Davis DR grading
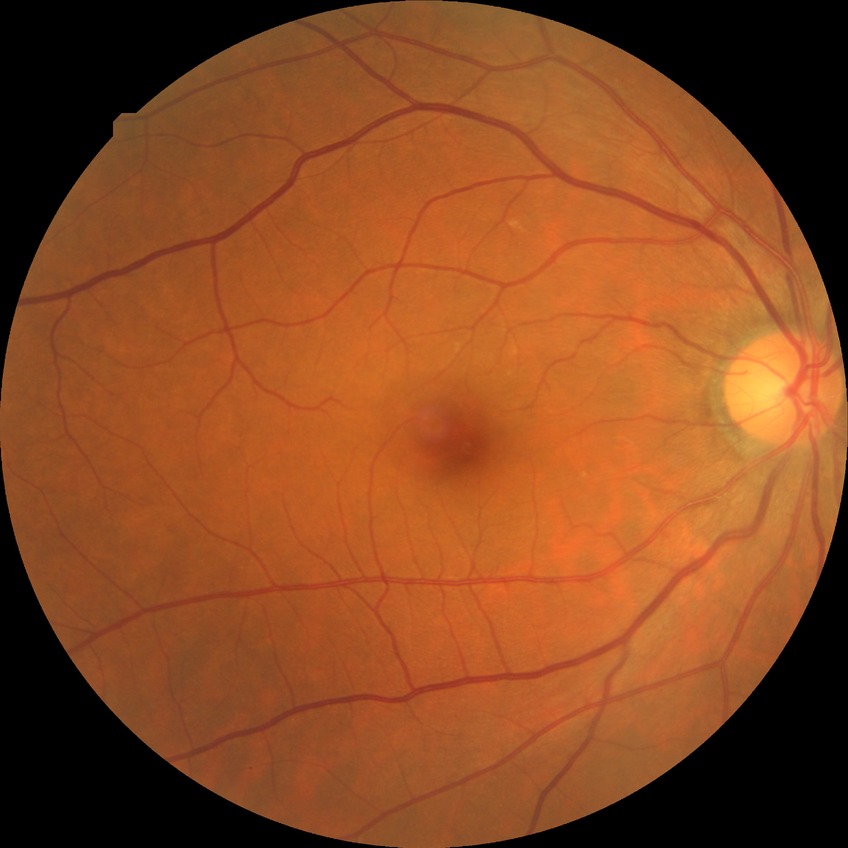 davis_grade: NDR (no diabetic retinopathy)